Color fundus image — 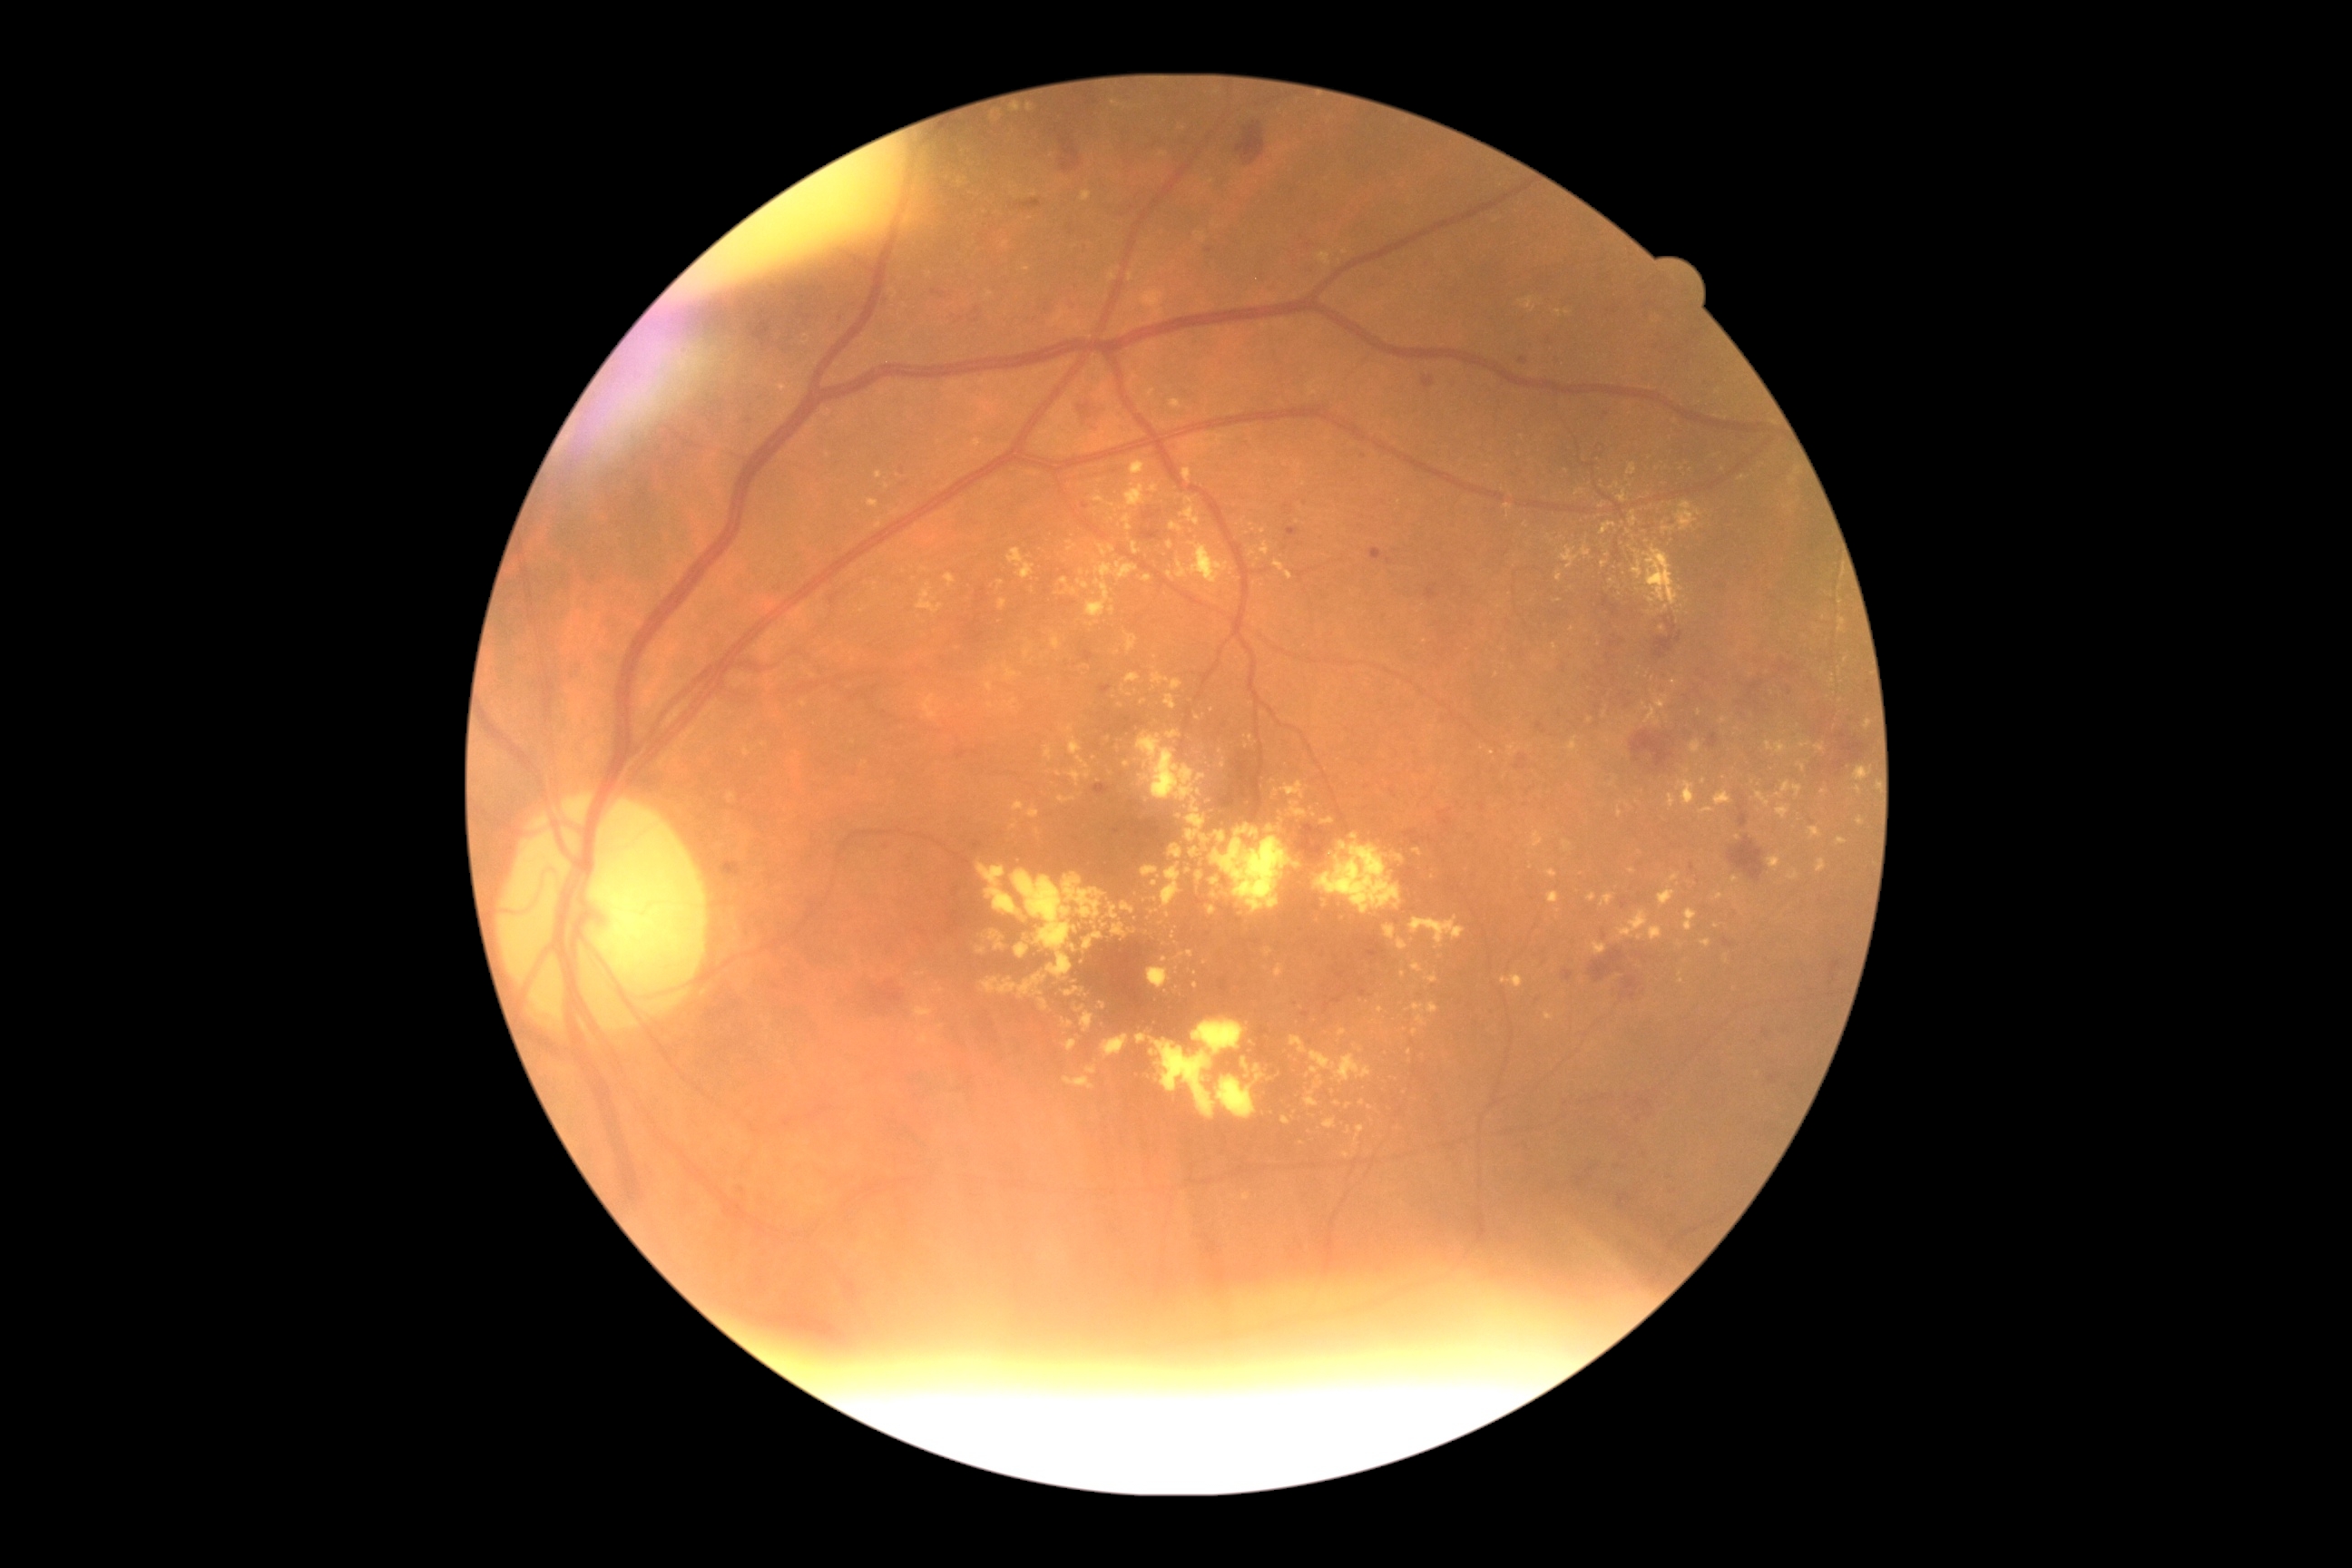 Diabetic retinopathy (DR) is 2
Representative lesions:
hard exudates (EXs) (continued): 1509, 745, 1518, 756 | 1398, 939, 1409, 950 | 1112, 101, 1121, 106 | 1378, 1006, 1384, 1014 | 995, 213, 1003, 220 | 1416, 1015, 1427, 1028 | 1208, 906, 1217, 916 | 1063, 1075, 1095, 1090 | 1126, 632, 1139, 654 | 1409, 917, 1465, 946 | 1012, 106, 1021, 113 | 1097, 544, 1108, 558 | 1054, 311, 1066, 326
Small EXs near [x=1605, y=715] | [x=1640, y=852] | [x=942, y=992] | [x=1188, y=871] | [x=1640, y=938] | [x=1162, y=924]